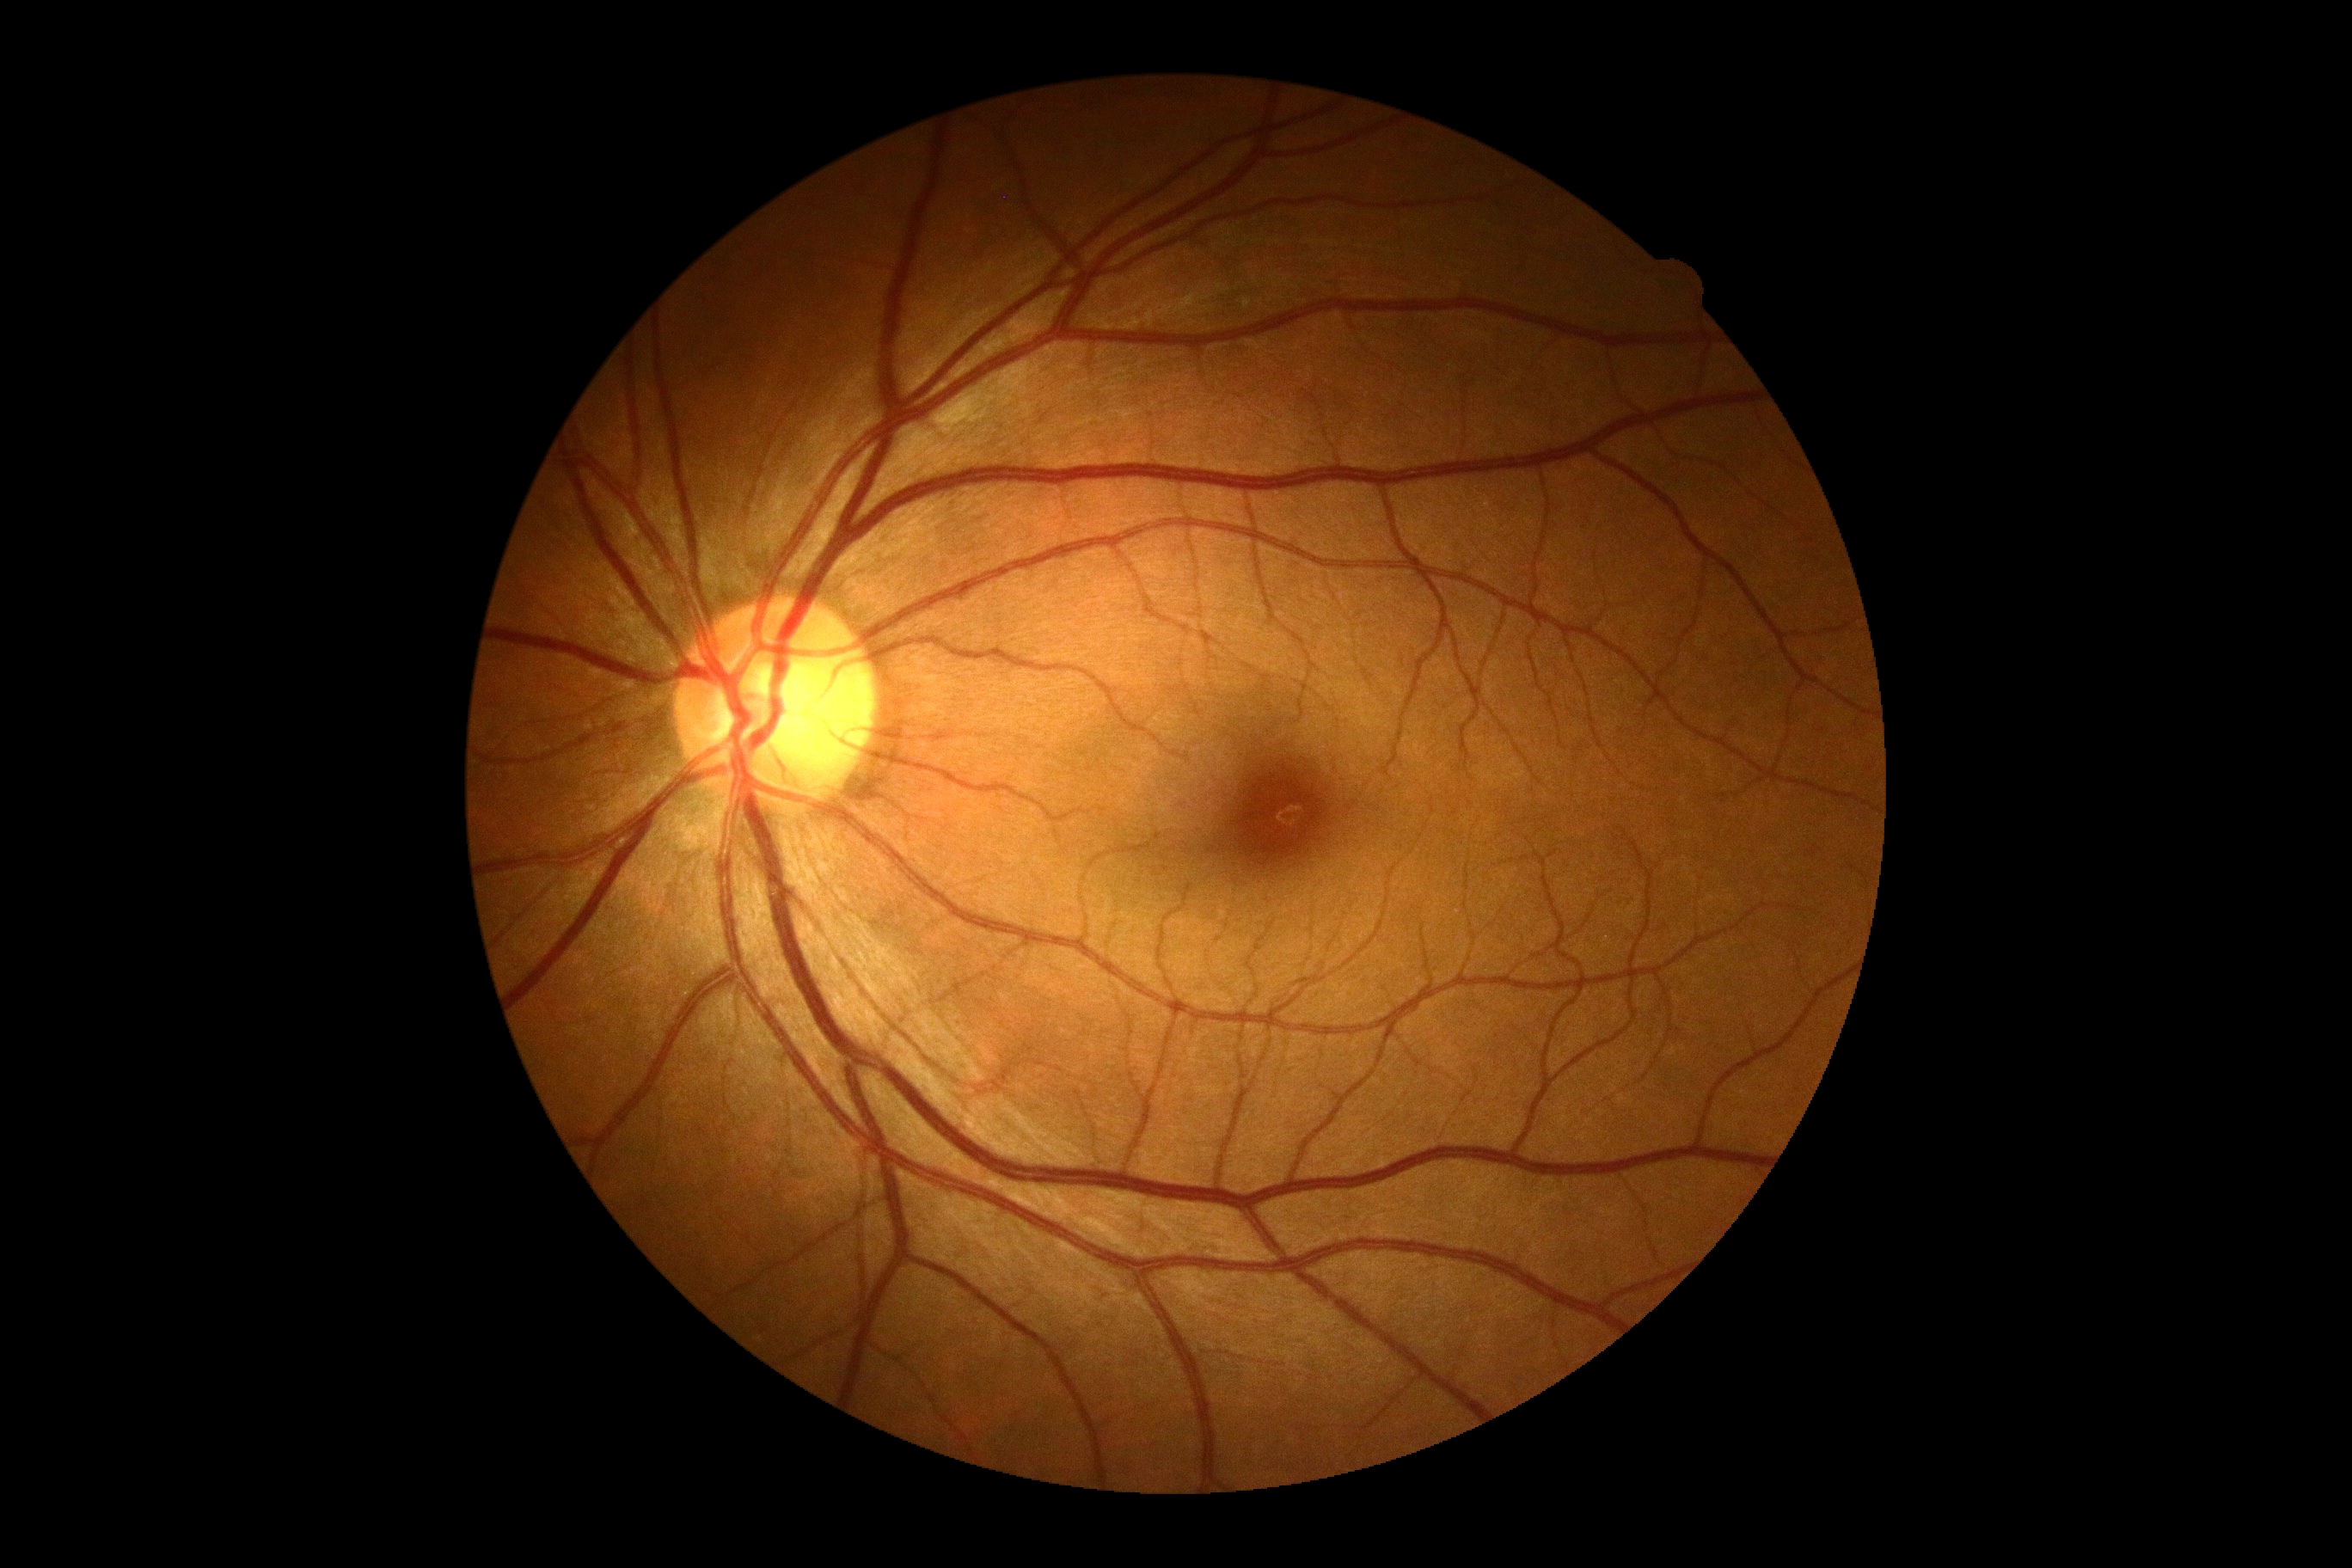
No diabetic retinal disease findings. Diabetic retinopathy severity: grade 0 (no apparent retinopathy).